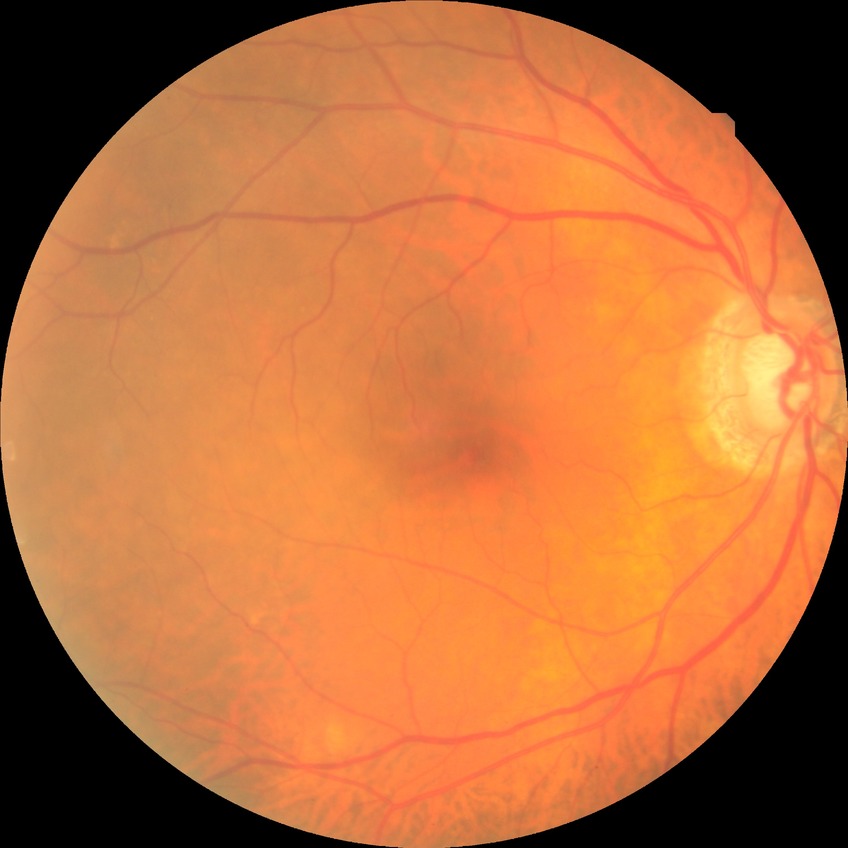

{
  "davis_grade": "NDR (no diabetic retinopathy)"
}